Camera: NIDEK AFC-230, 45° field of view, 848 x 848 pixels: 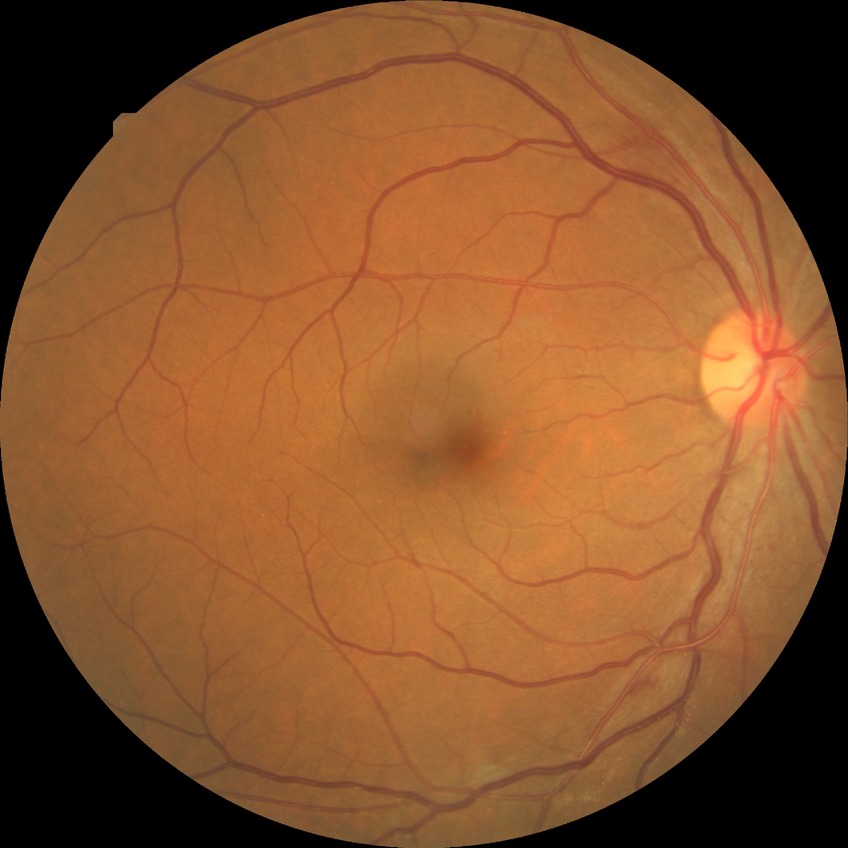 Diabetic retinopathy (DR): SDR (simple diabetic retinopathy).